Pediatric retinal photograph (wide-field). 640 by 480 pixels
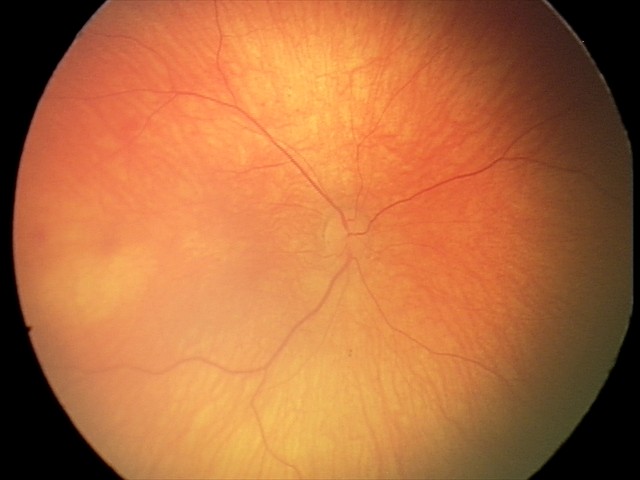

Examination with physiological retinal findings.